2352x1568; 45° FOV; color fundus image: 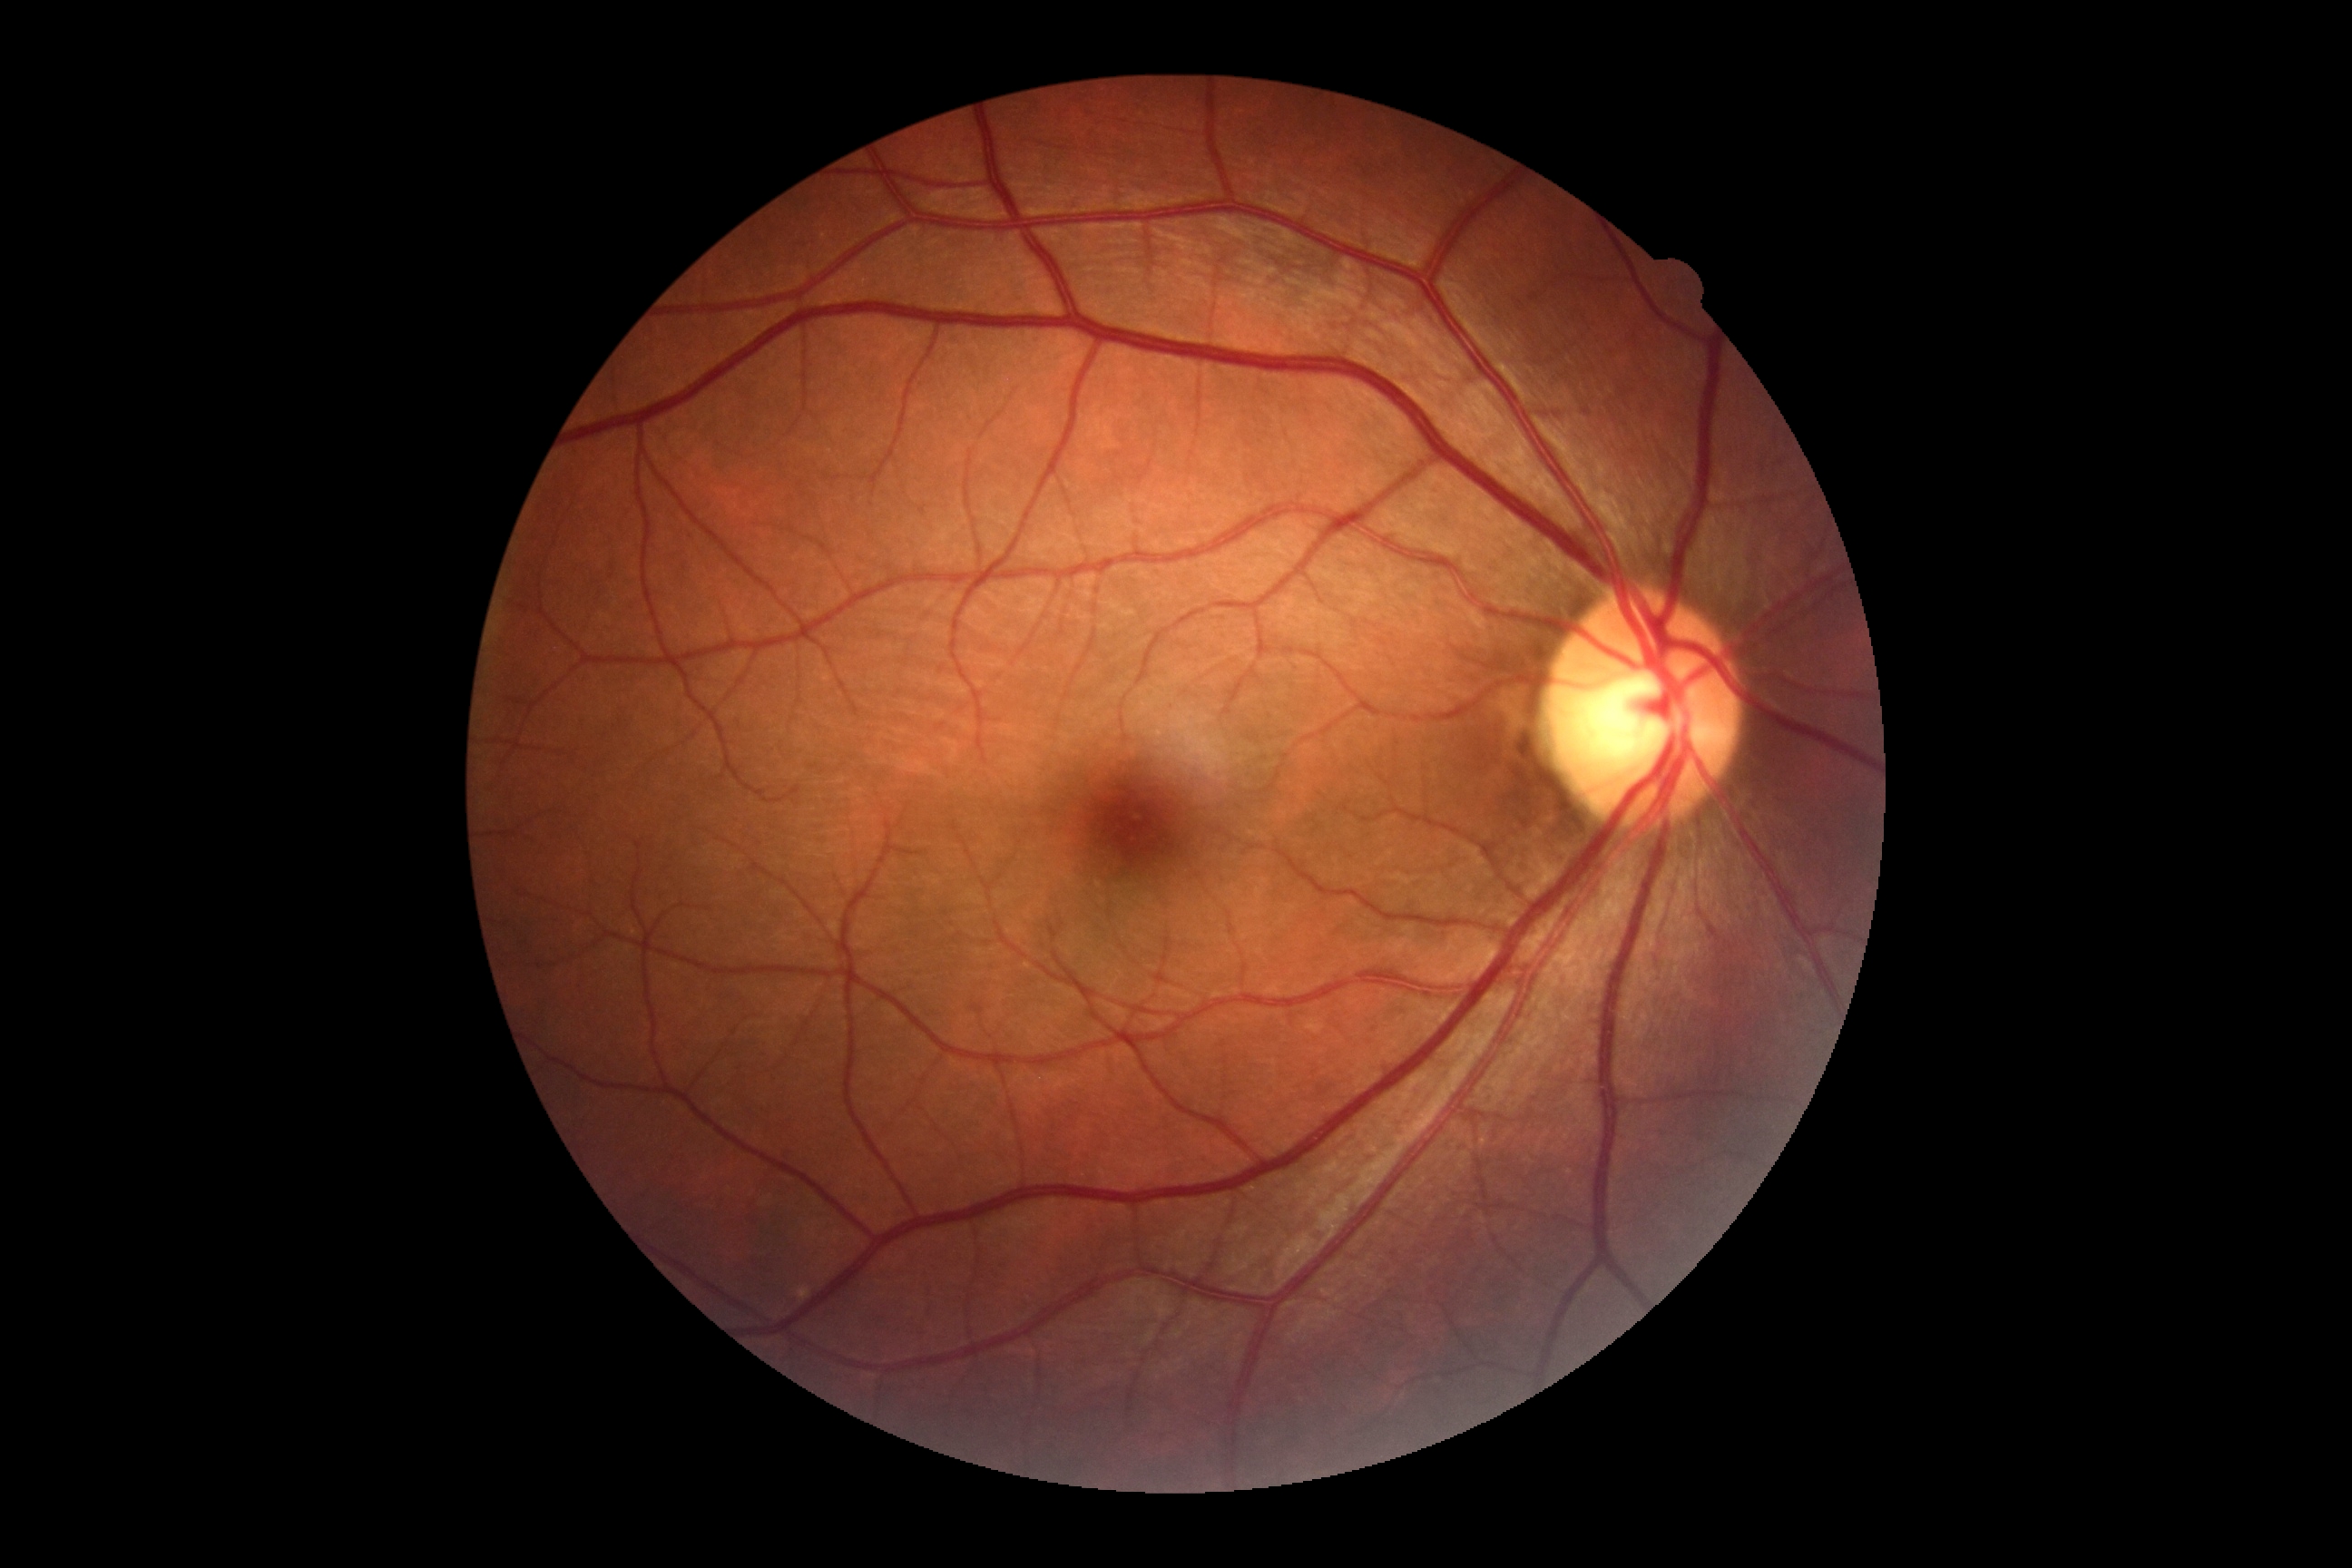 retinopathy grade: 0/4.